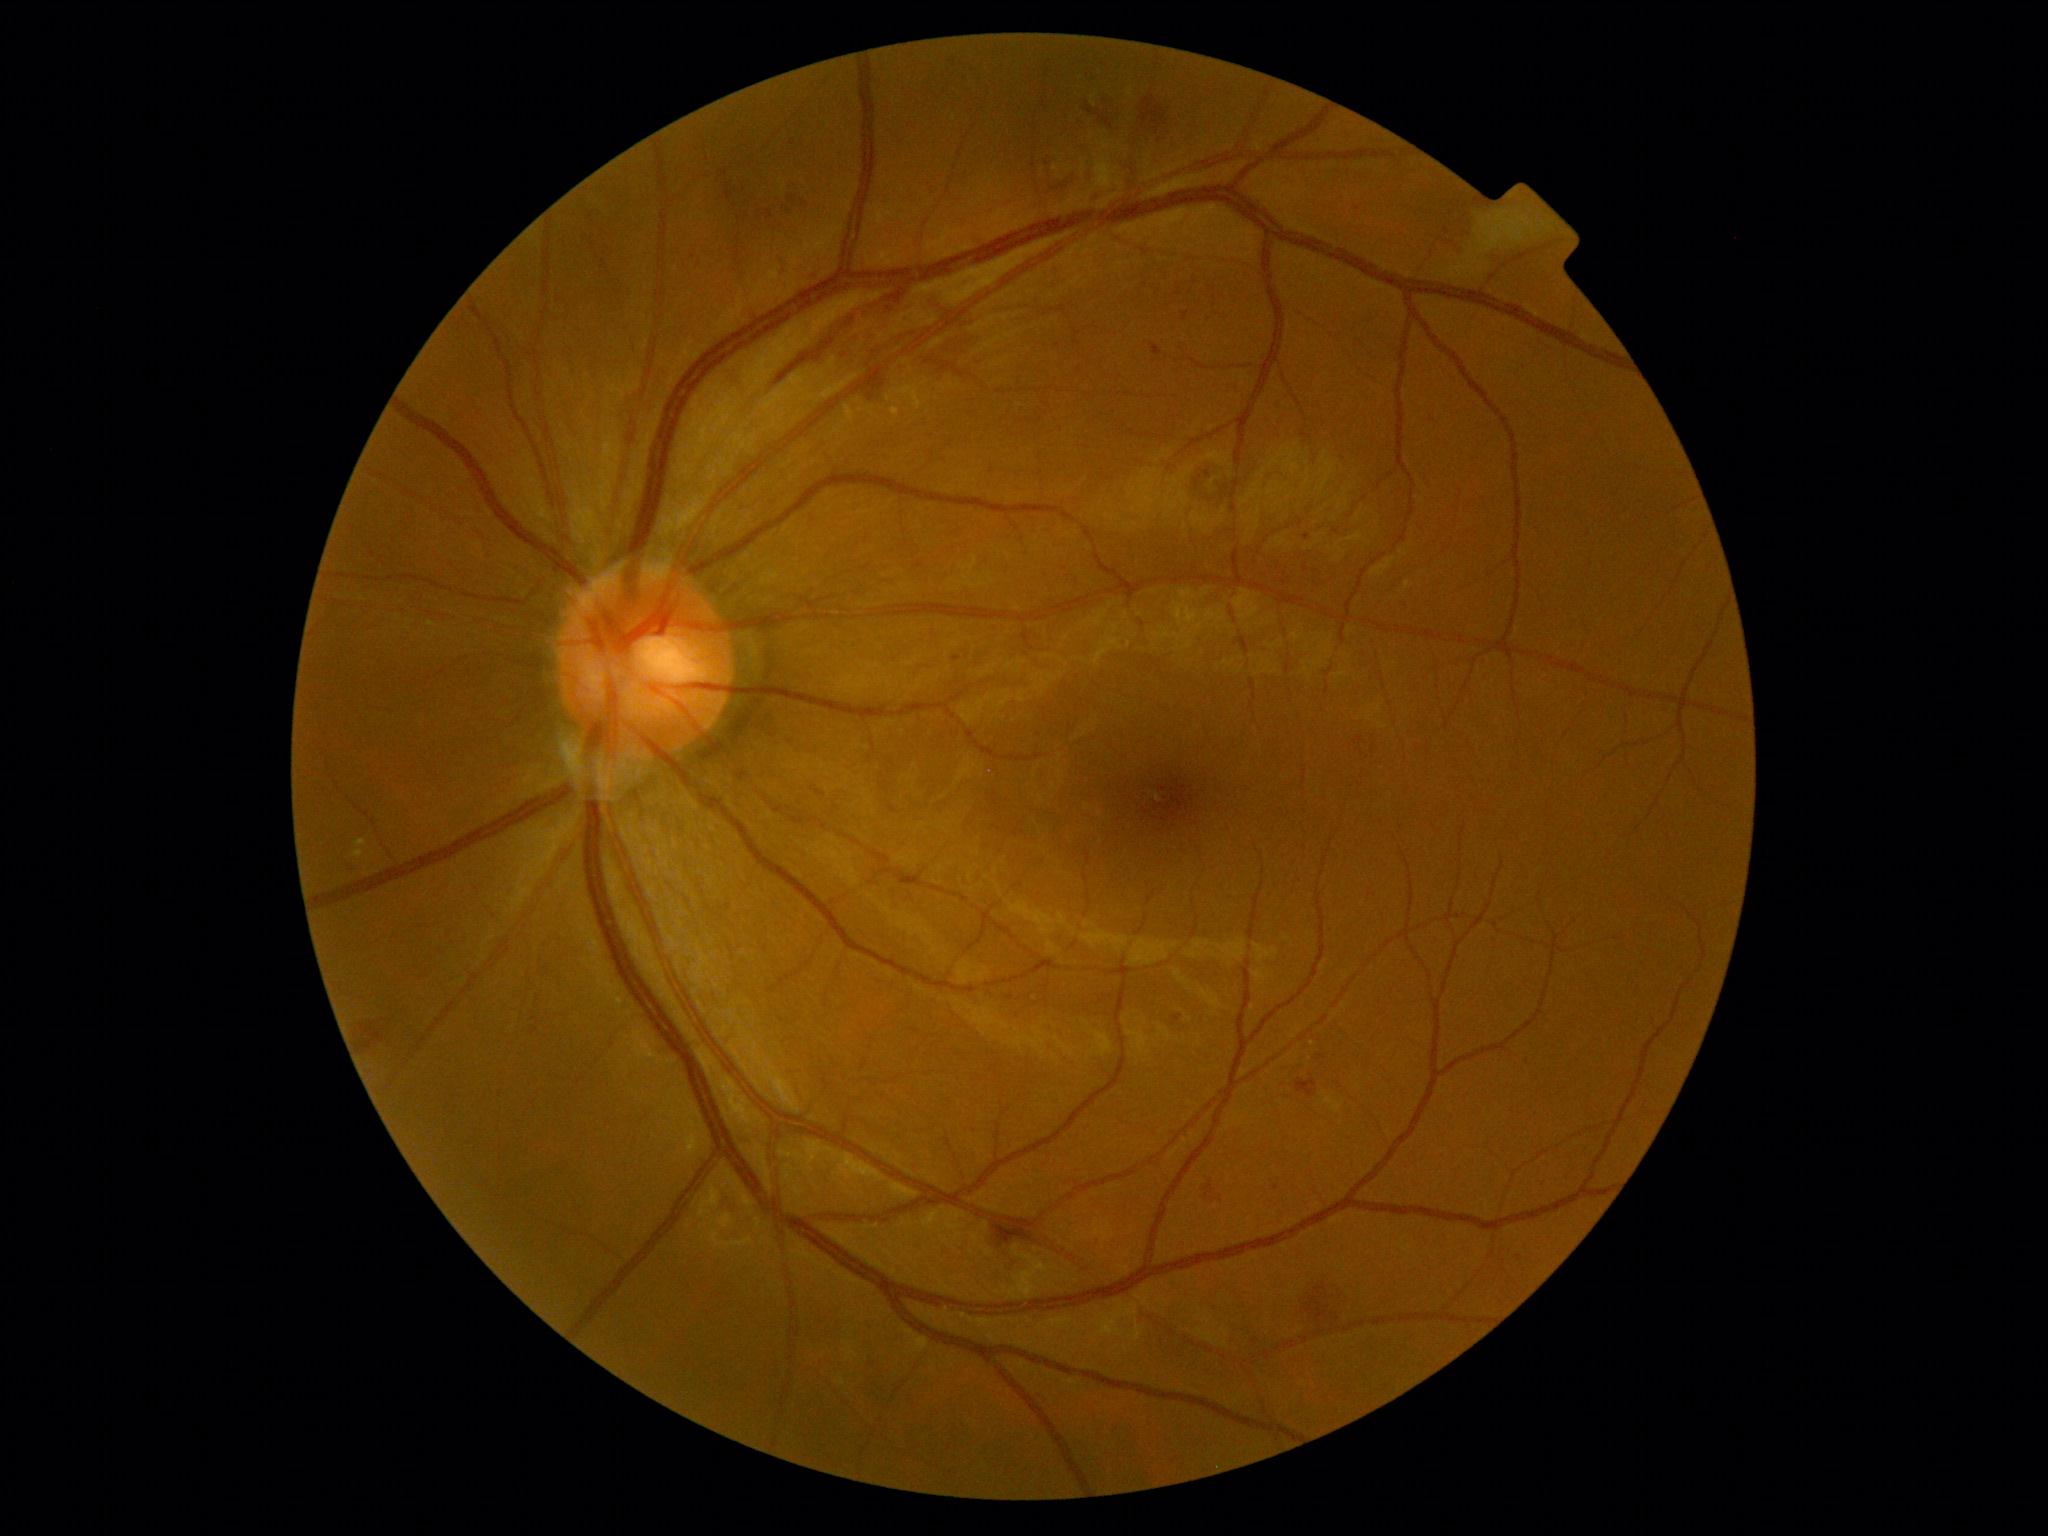
DR stage is grade 2 (moderate NPDR).
EXs identified at rect(1096, 158, 1116, 189); rect(354, 849, 364, 859); rect(845, 405, 855, 422); rect(891, 408, 900, 418); rect(354, 839, 367, 848); rect(1479, 212, 1535, 255).
No SEs identified.
HEs identified at rect(1297, 1078, 1317, 1097); rect(360, 1022, 388, 1045); rect(779, 258, 788, 278); rect(1089, 96, 1119, 129); rect(1052, 176, 1075, 202); rect(807, 271, 817, 281); rect(1205, 1183, 1218, 1201); rect(1317, 1286, 1344, 1324); rect(1139, 97, 1166, 135); rect(778, 286, 949, 385); rect(719, 181, 761, 239); rect(992, 1216, 1039, 1246); rect(781, 202, 798, 218).
MAs are present, including at rect(953, 656, 961, 662); rect(1184, 312, 1189, 321); rect(1151, 344, 1162, 357); rect(1173, 1015, 1182, 1022).
Additional small MAs near 1519:1258; 1277:1188; 1307:537.